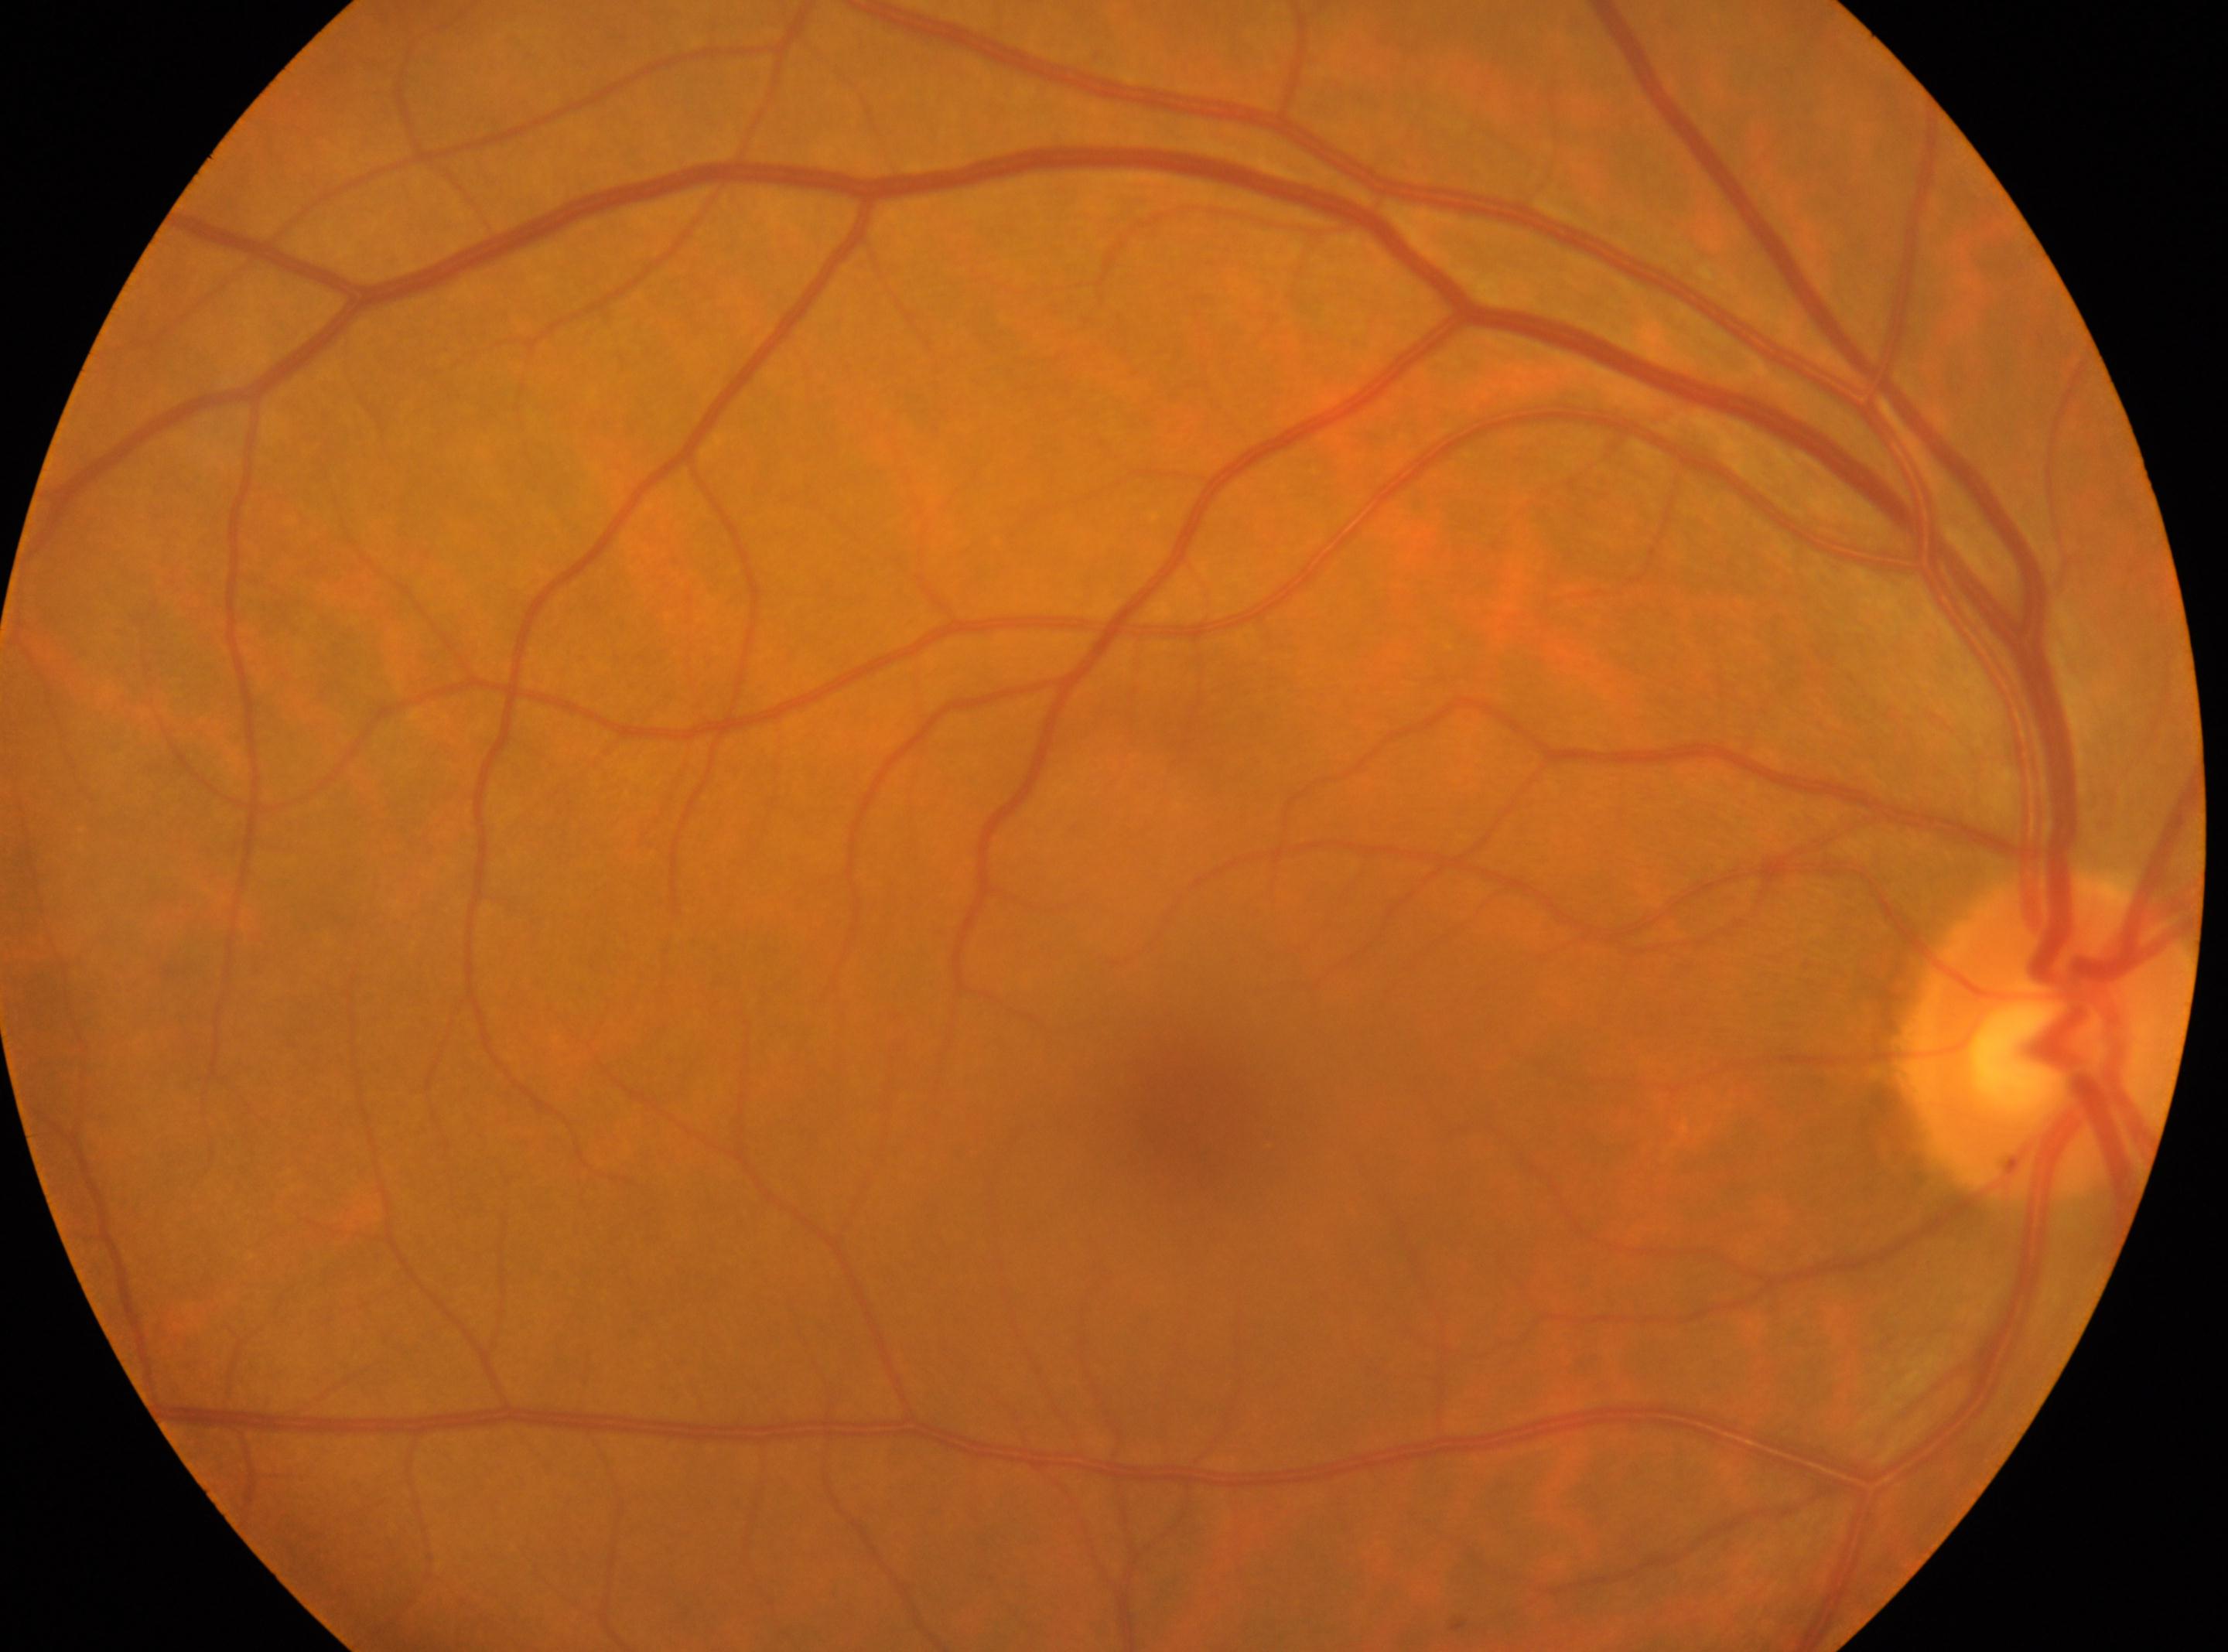

| feature | annotation |
|---|---|
| laterality | right eye |
| foveal center | 1194px, 1112px |
| disc center | 2046px, 1038px |
| DR stage | grade 0 (no apparent retinopathy) |